2048x1536. 45° field of view. Retinal fundus photograph.
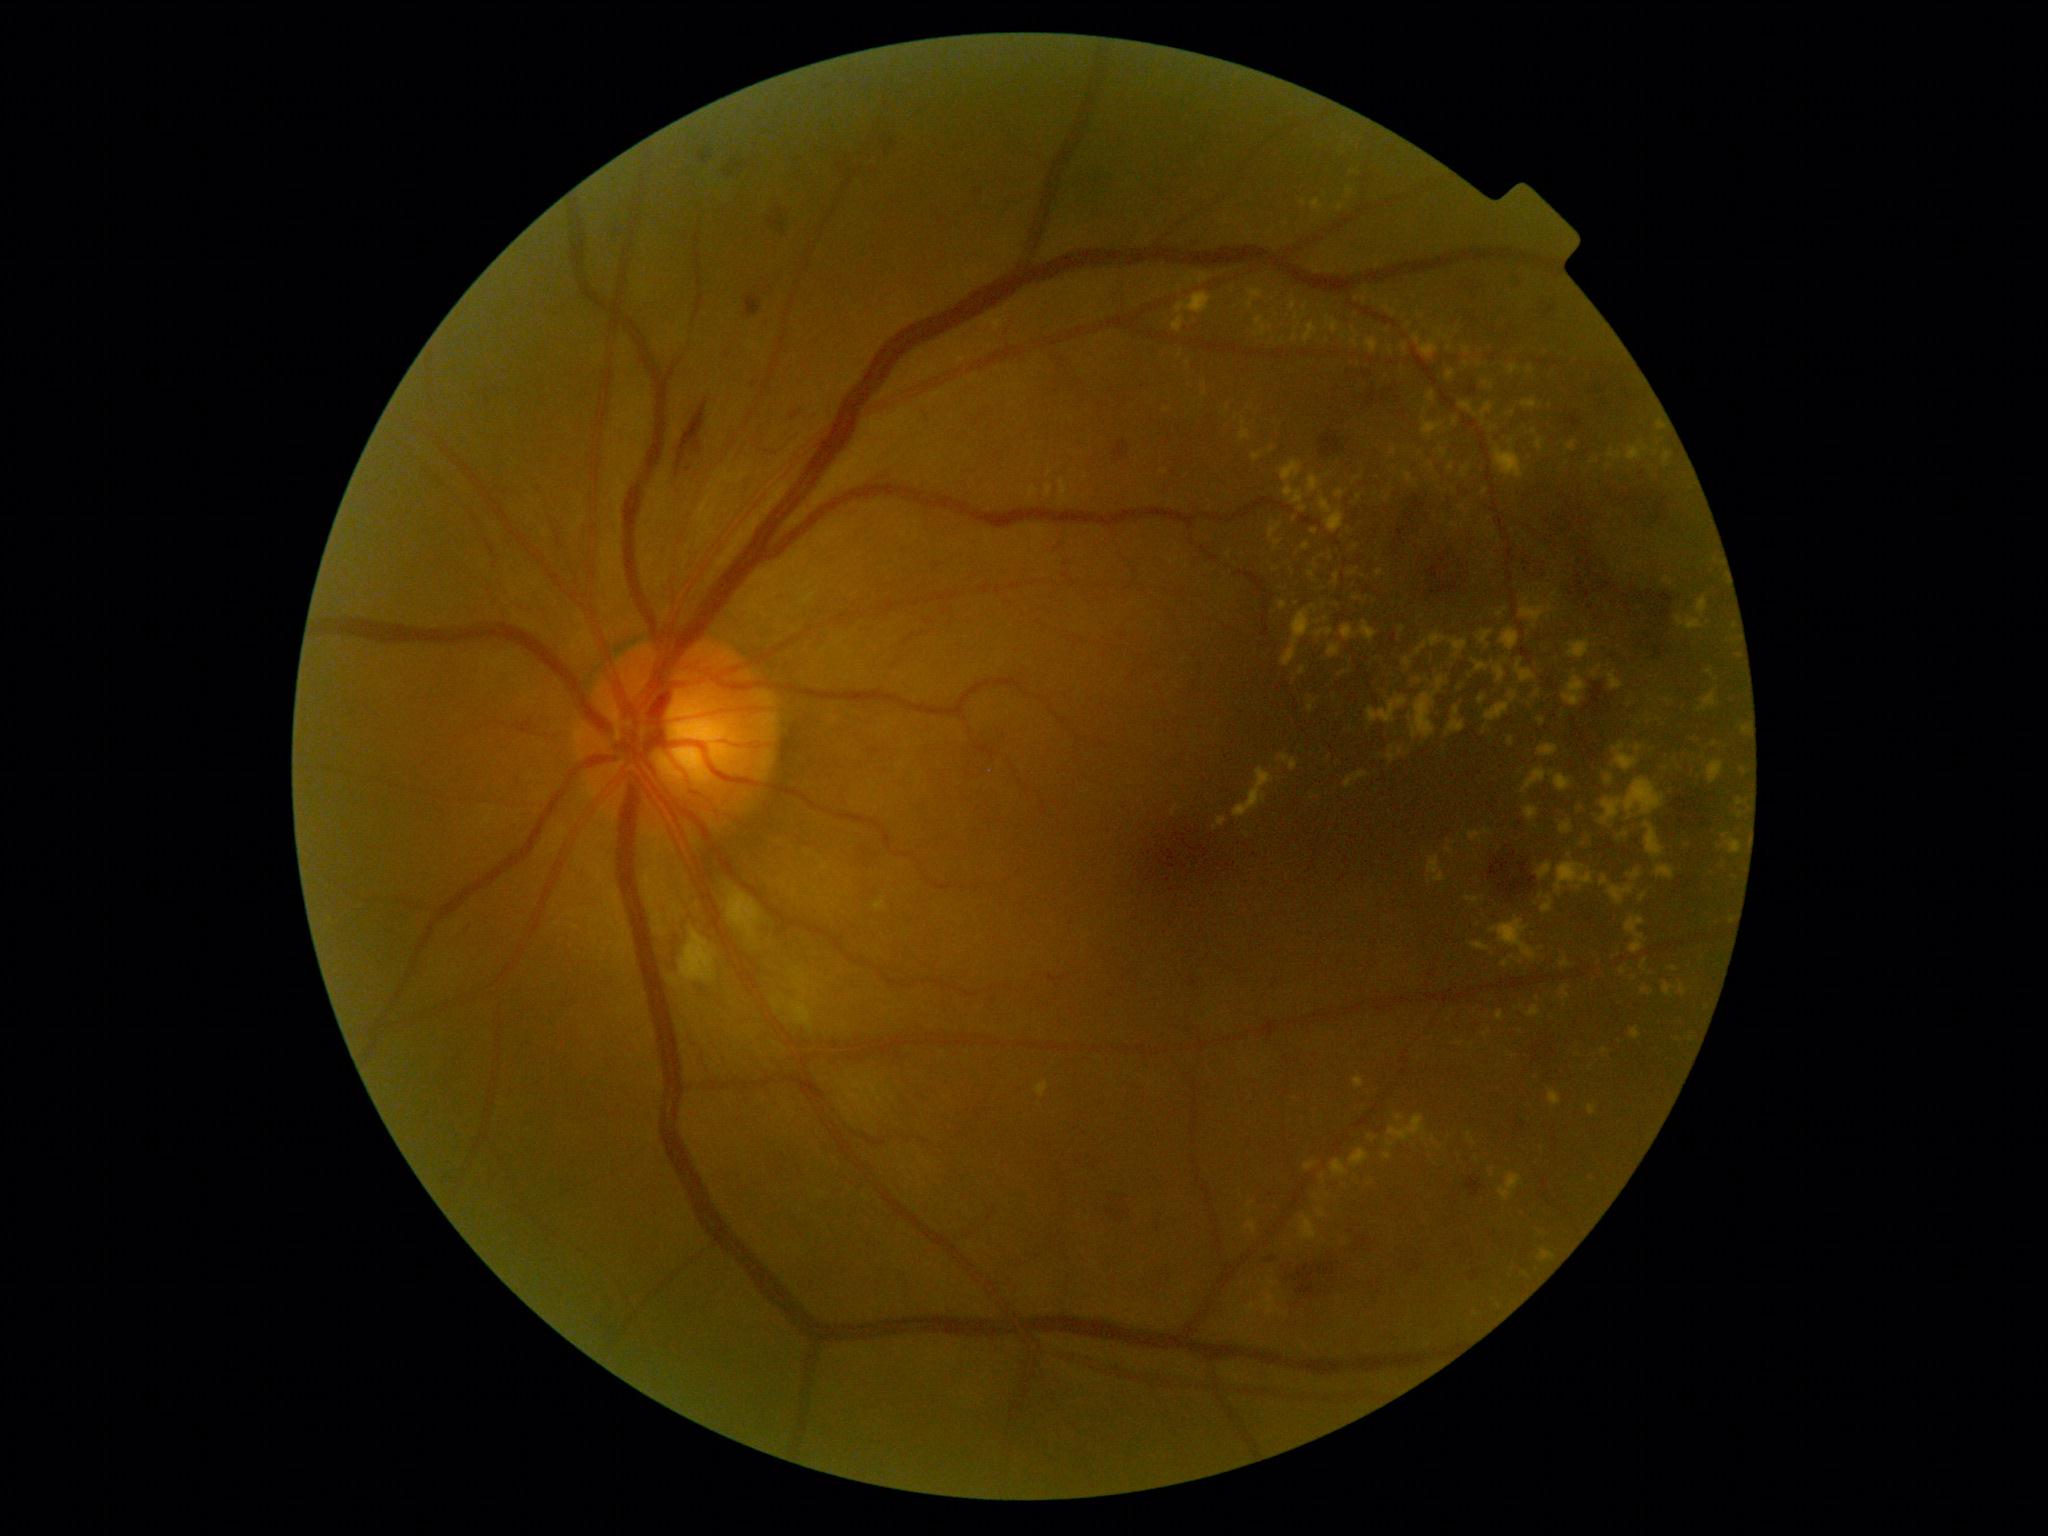 retinopathy grade: 2 (moderate NPDR).